640x480; camera: Clarity RetCam 3 (130° FOV); RetCam wide-field infant fundus image
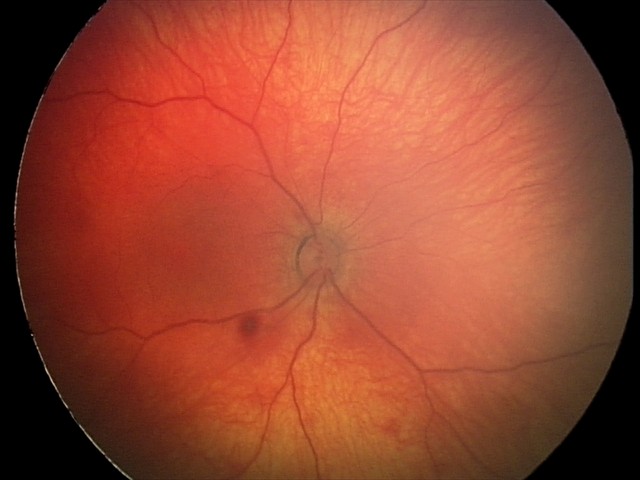

Screening examination consistent with retinal hemorrhages.